2184x1691px.
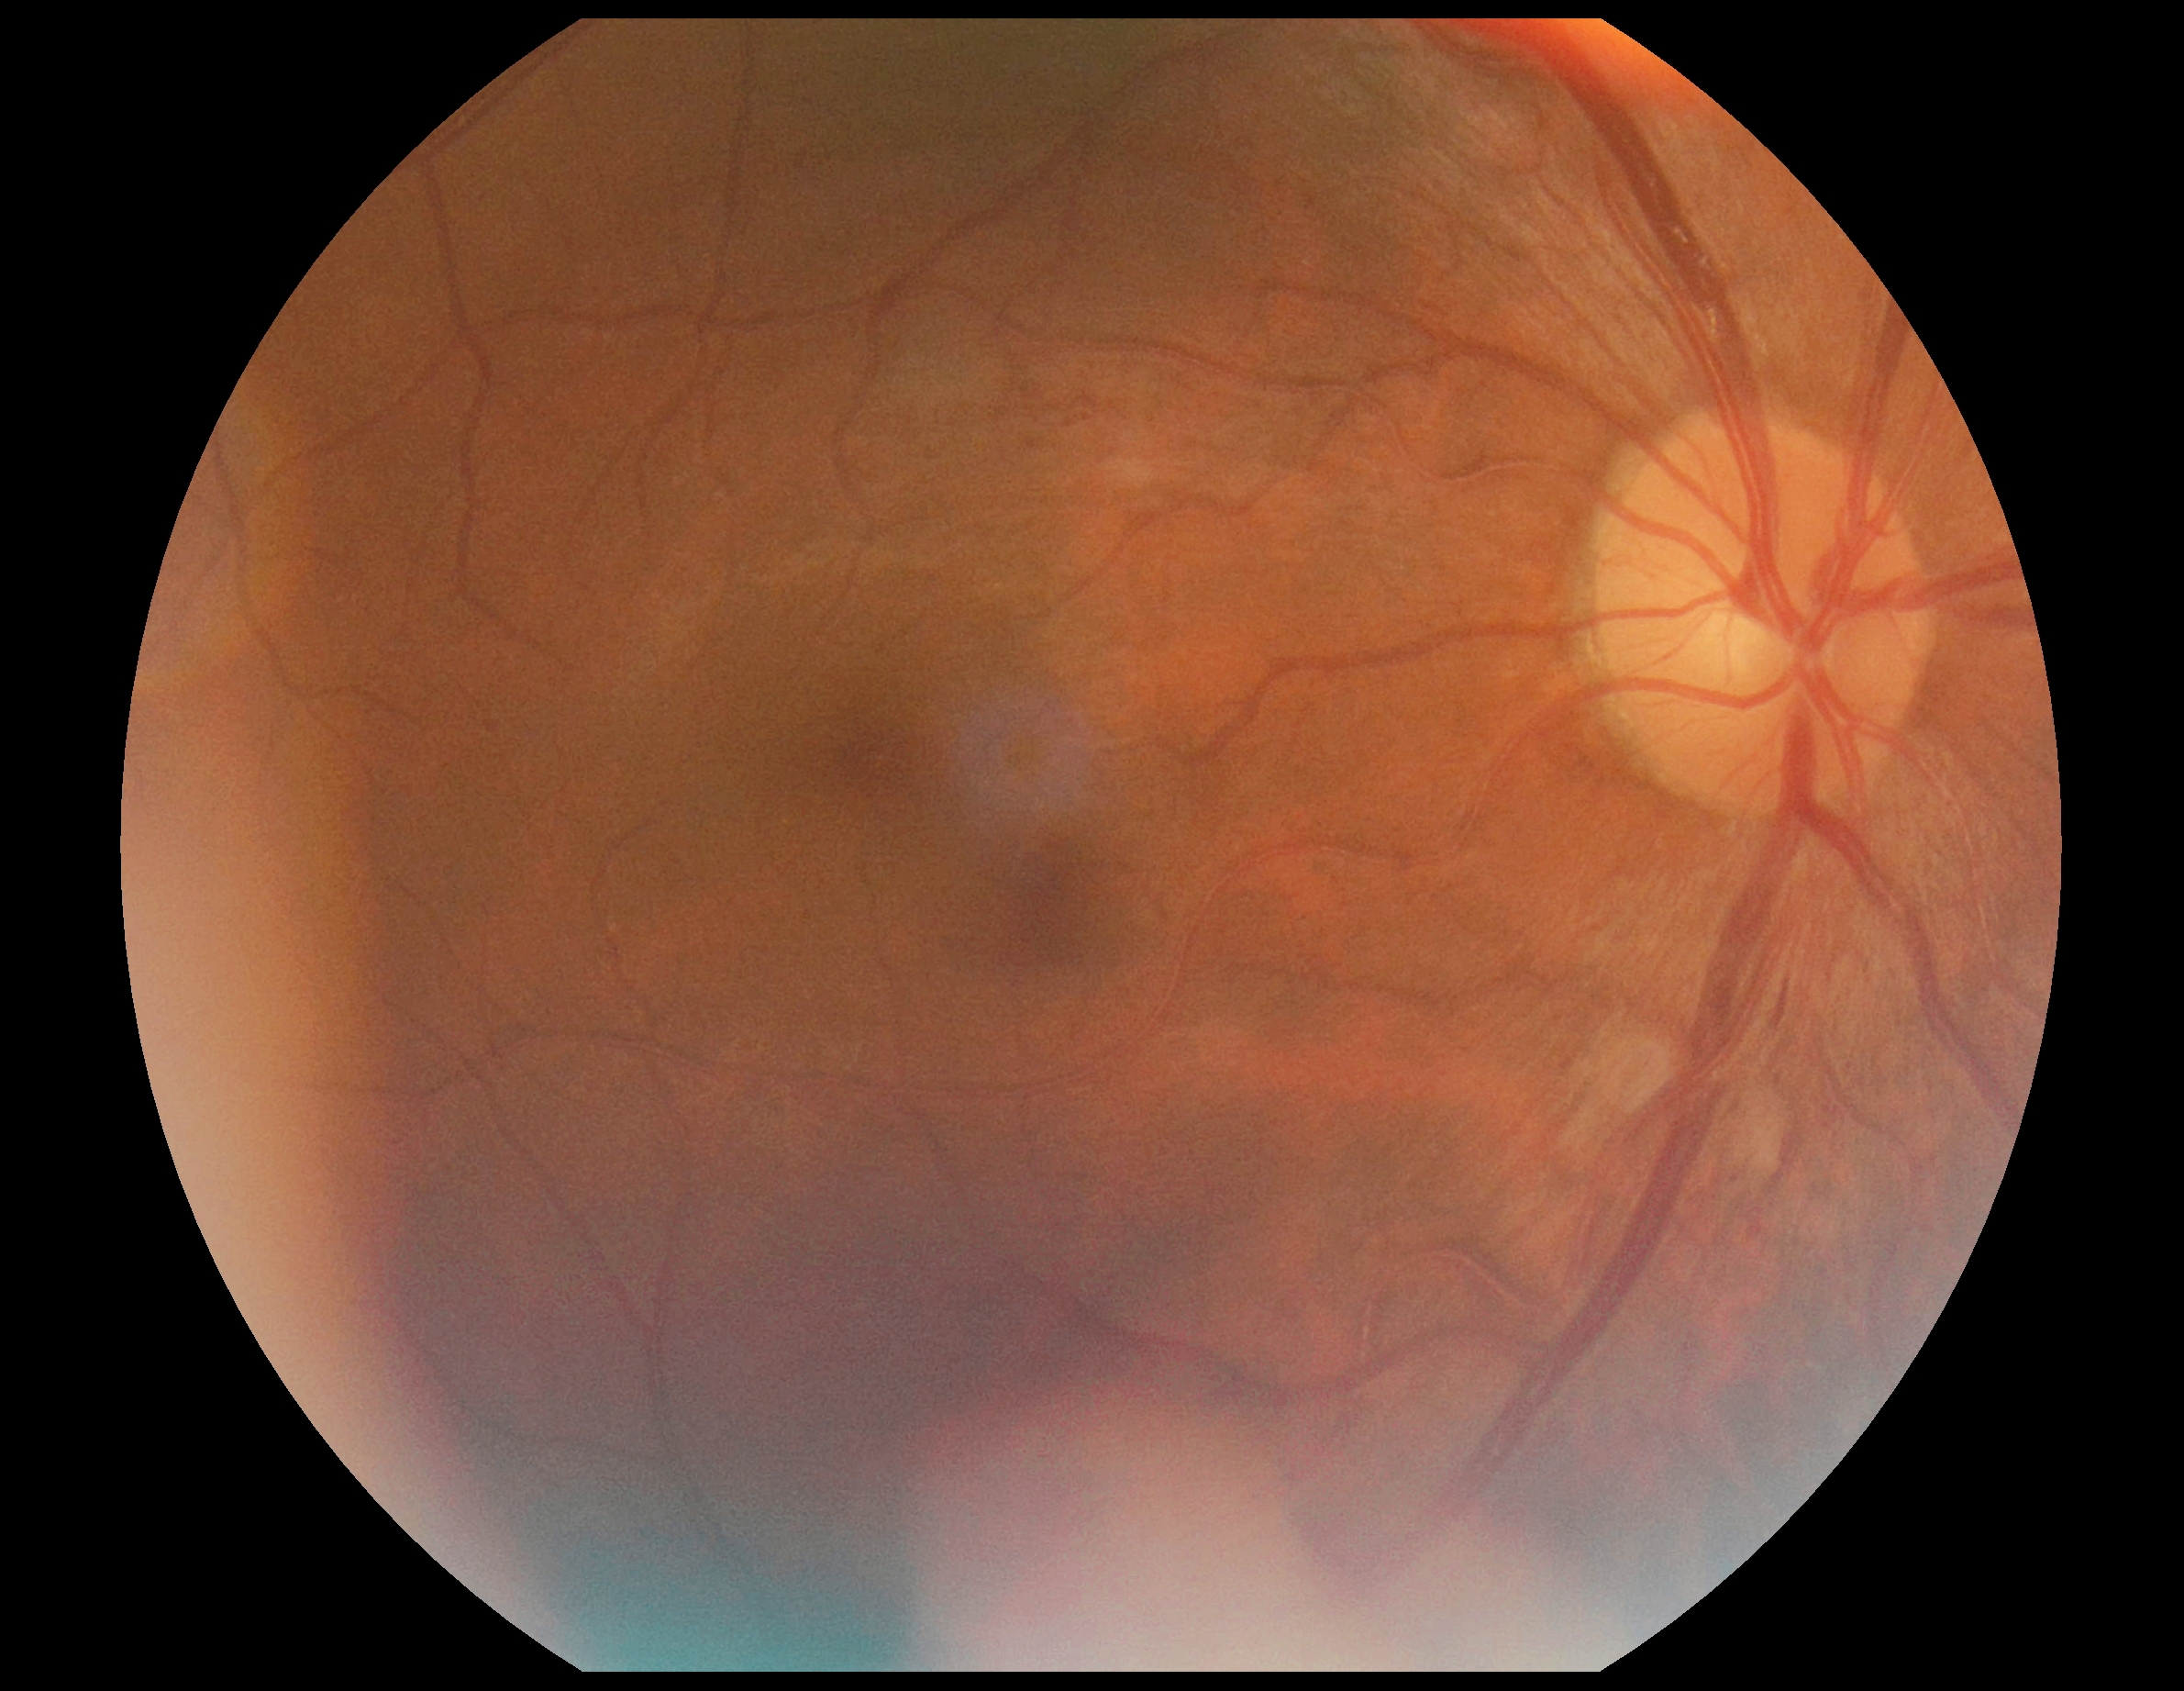
Retinopathy grade: 2.